45° FOV; tabletop color fundus camera image
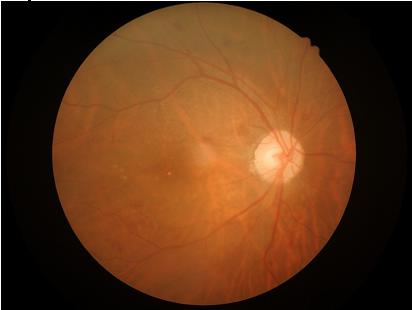
Sharpness = clear
Overall quality = good
Illumination/color = adequate
Contrast = satisfactory